Wide-field fundus photograph of an infant. Clarity RetCam 3, 130° FOV.
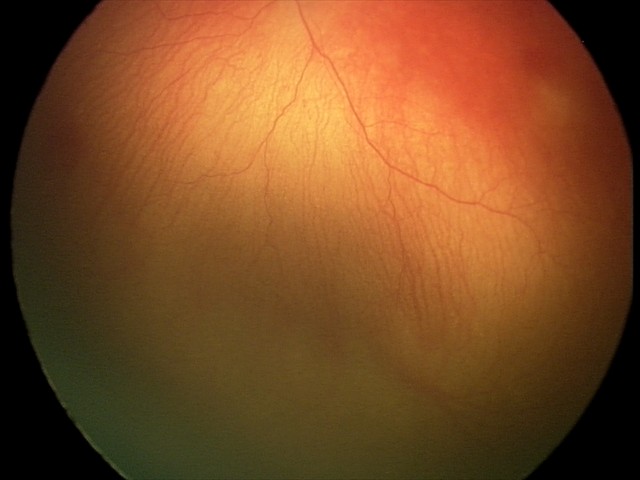

Plus disease was diagnosed.
Examination diagnosed as aggressive ROP (A-ROP).